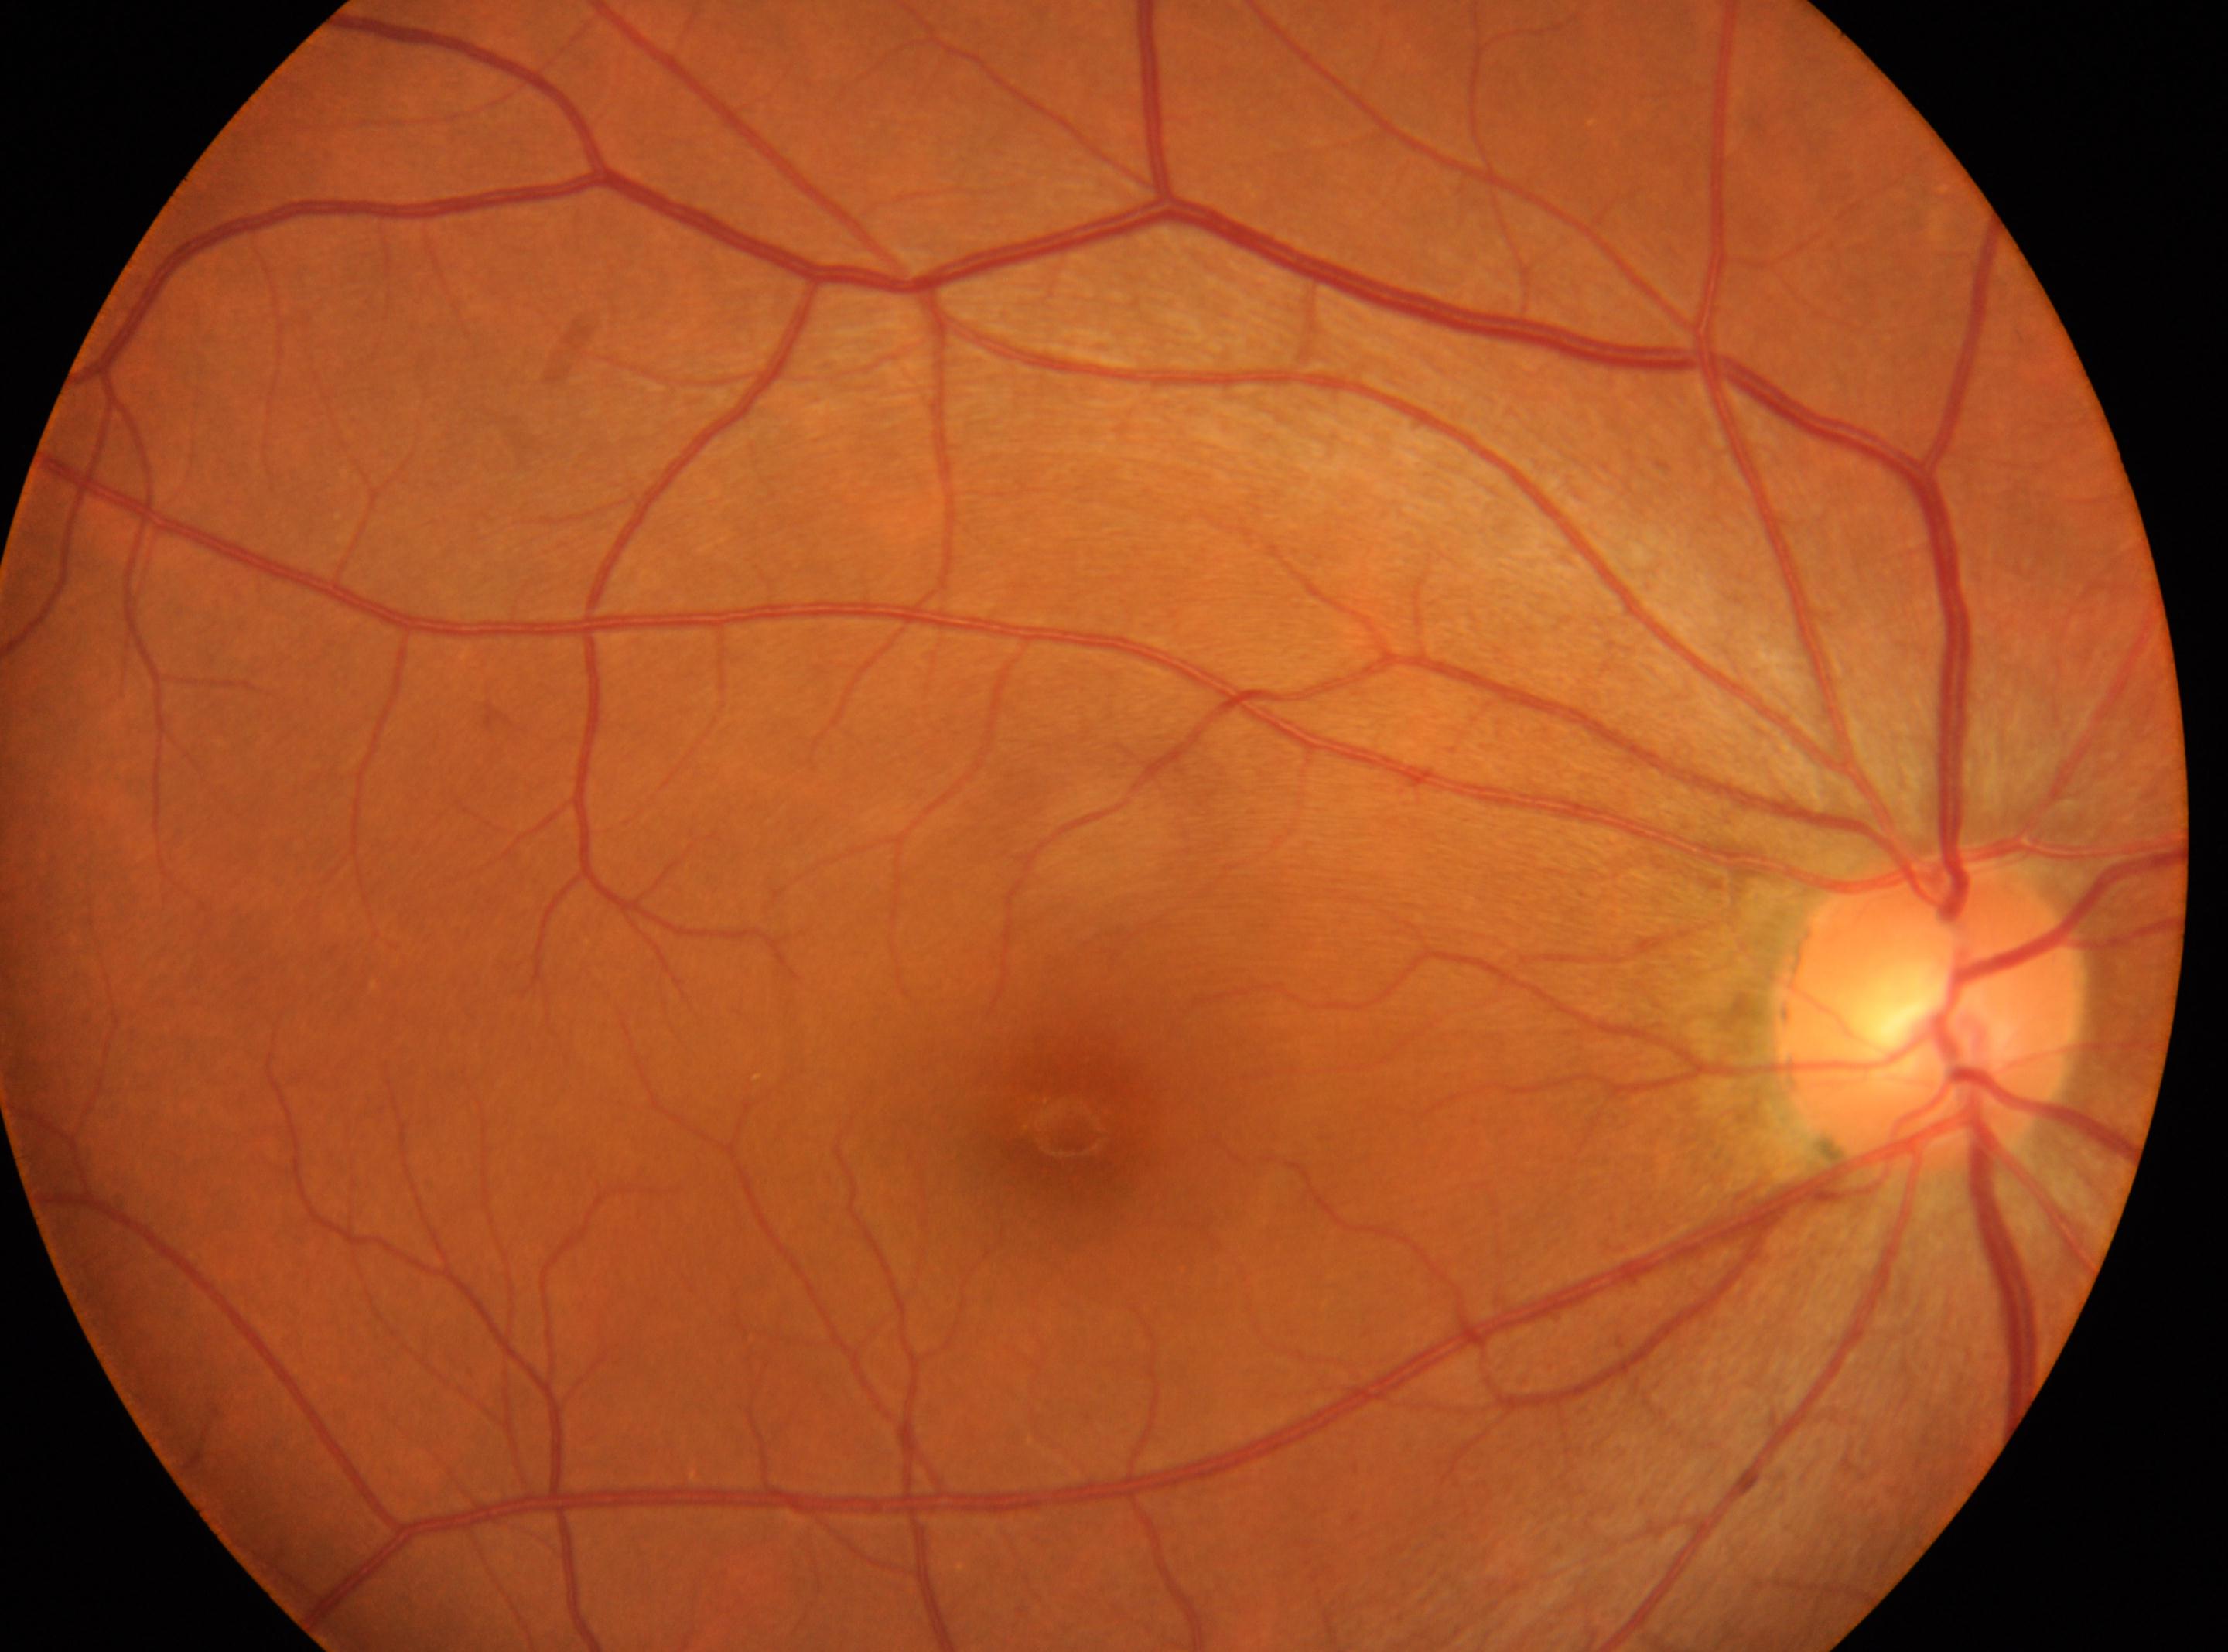

ONH: x=1927, y=1010.
DR stage: no apparent diabetic retinopathy (grade 0).
The fovea is at x=1072, y=1134.
This is the OD.
No diabetic retinopathy identified.